100° field of view (Phoenix ICON). Infant wide-field retinal image:
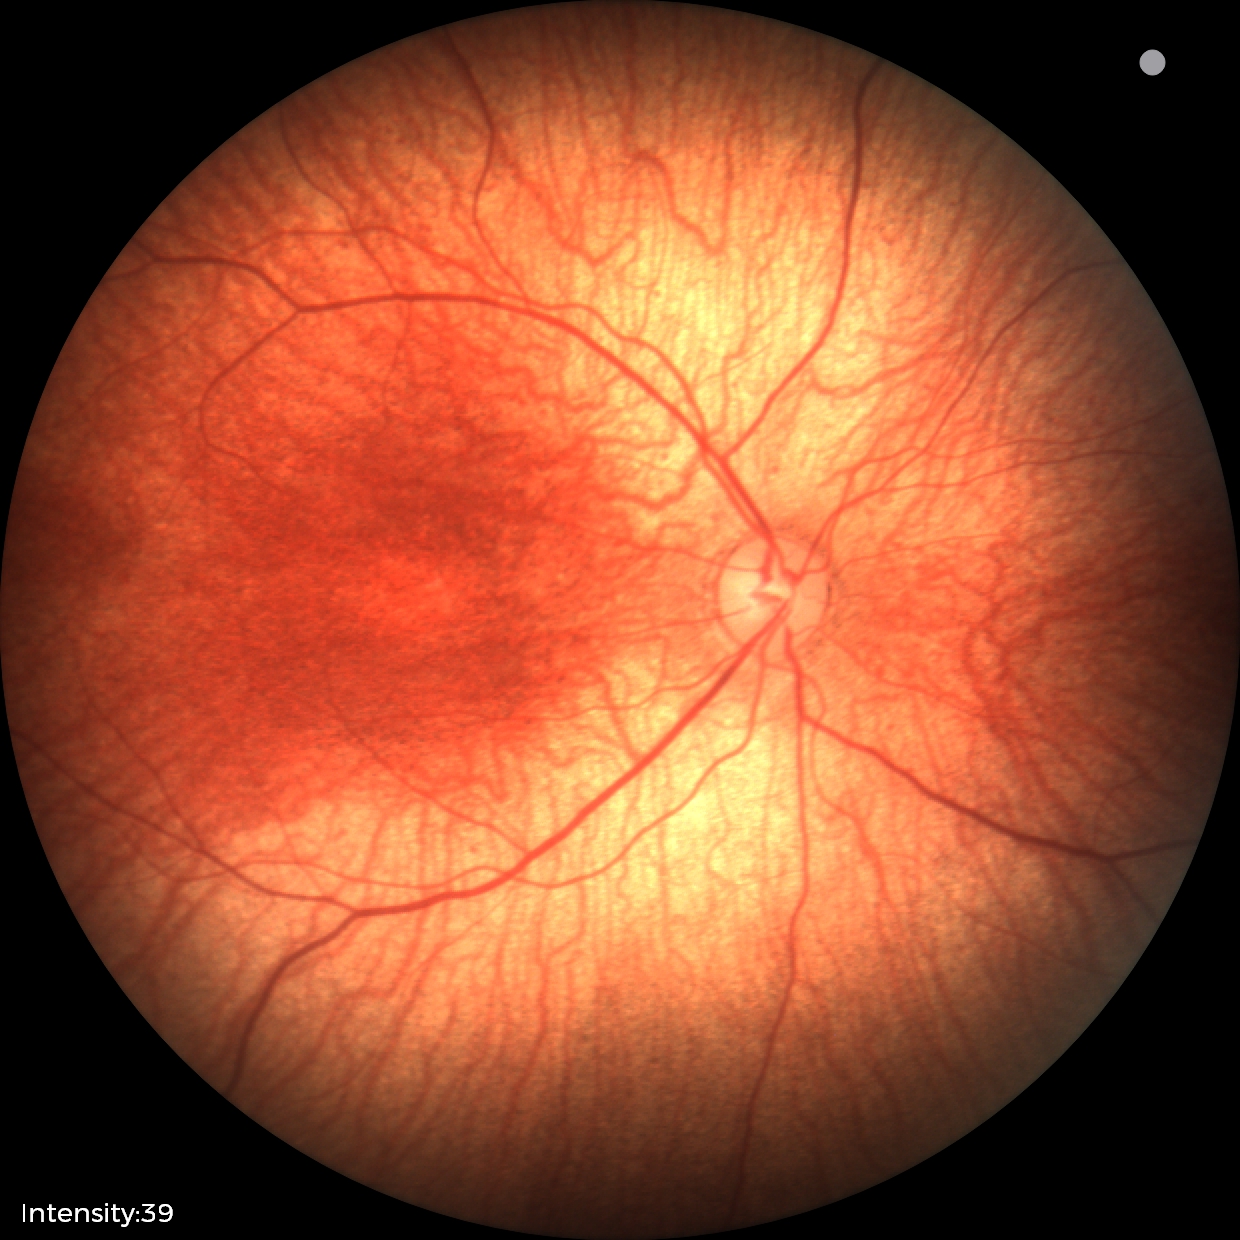 Normal screening examination.